Retinal fundus photograph · 1932 by 1910 pixels · FOV: 45 degrees.
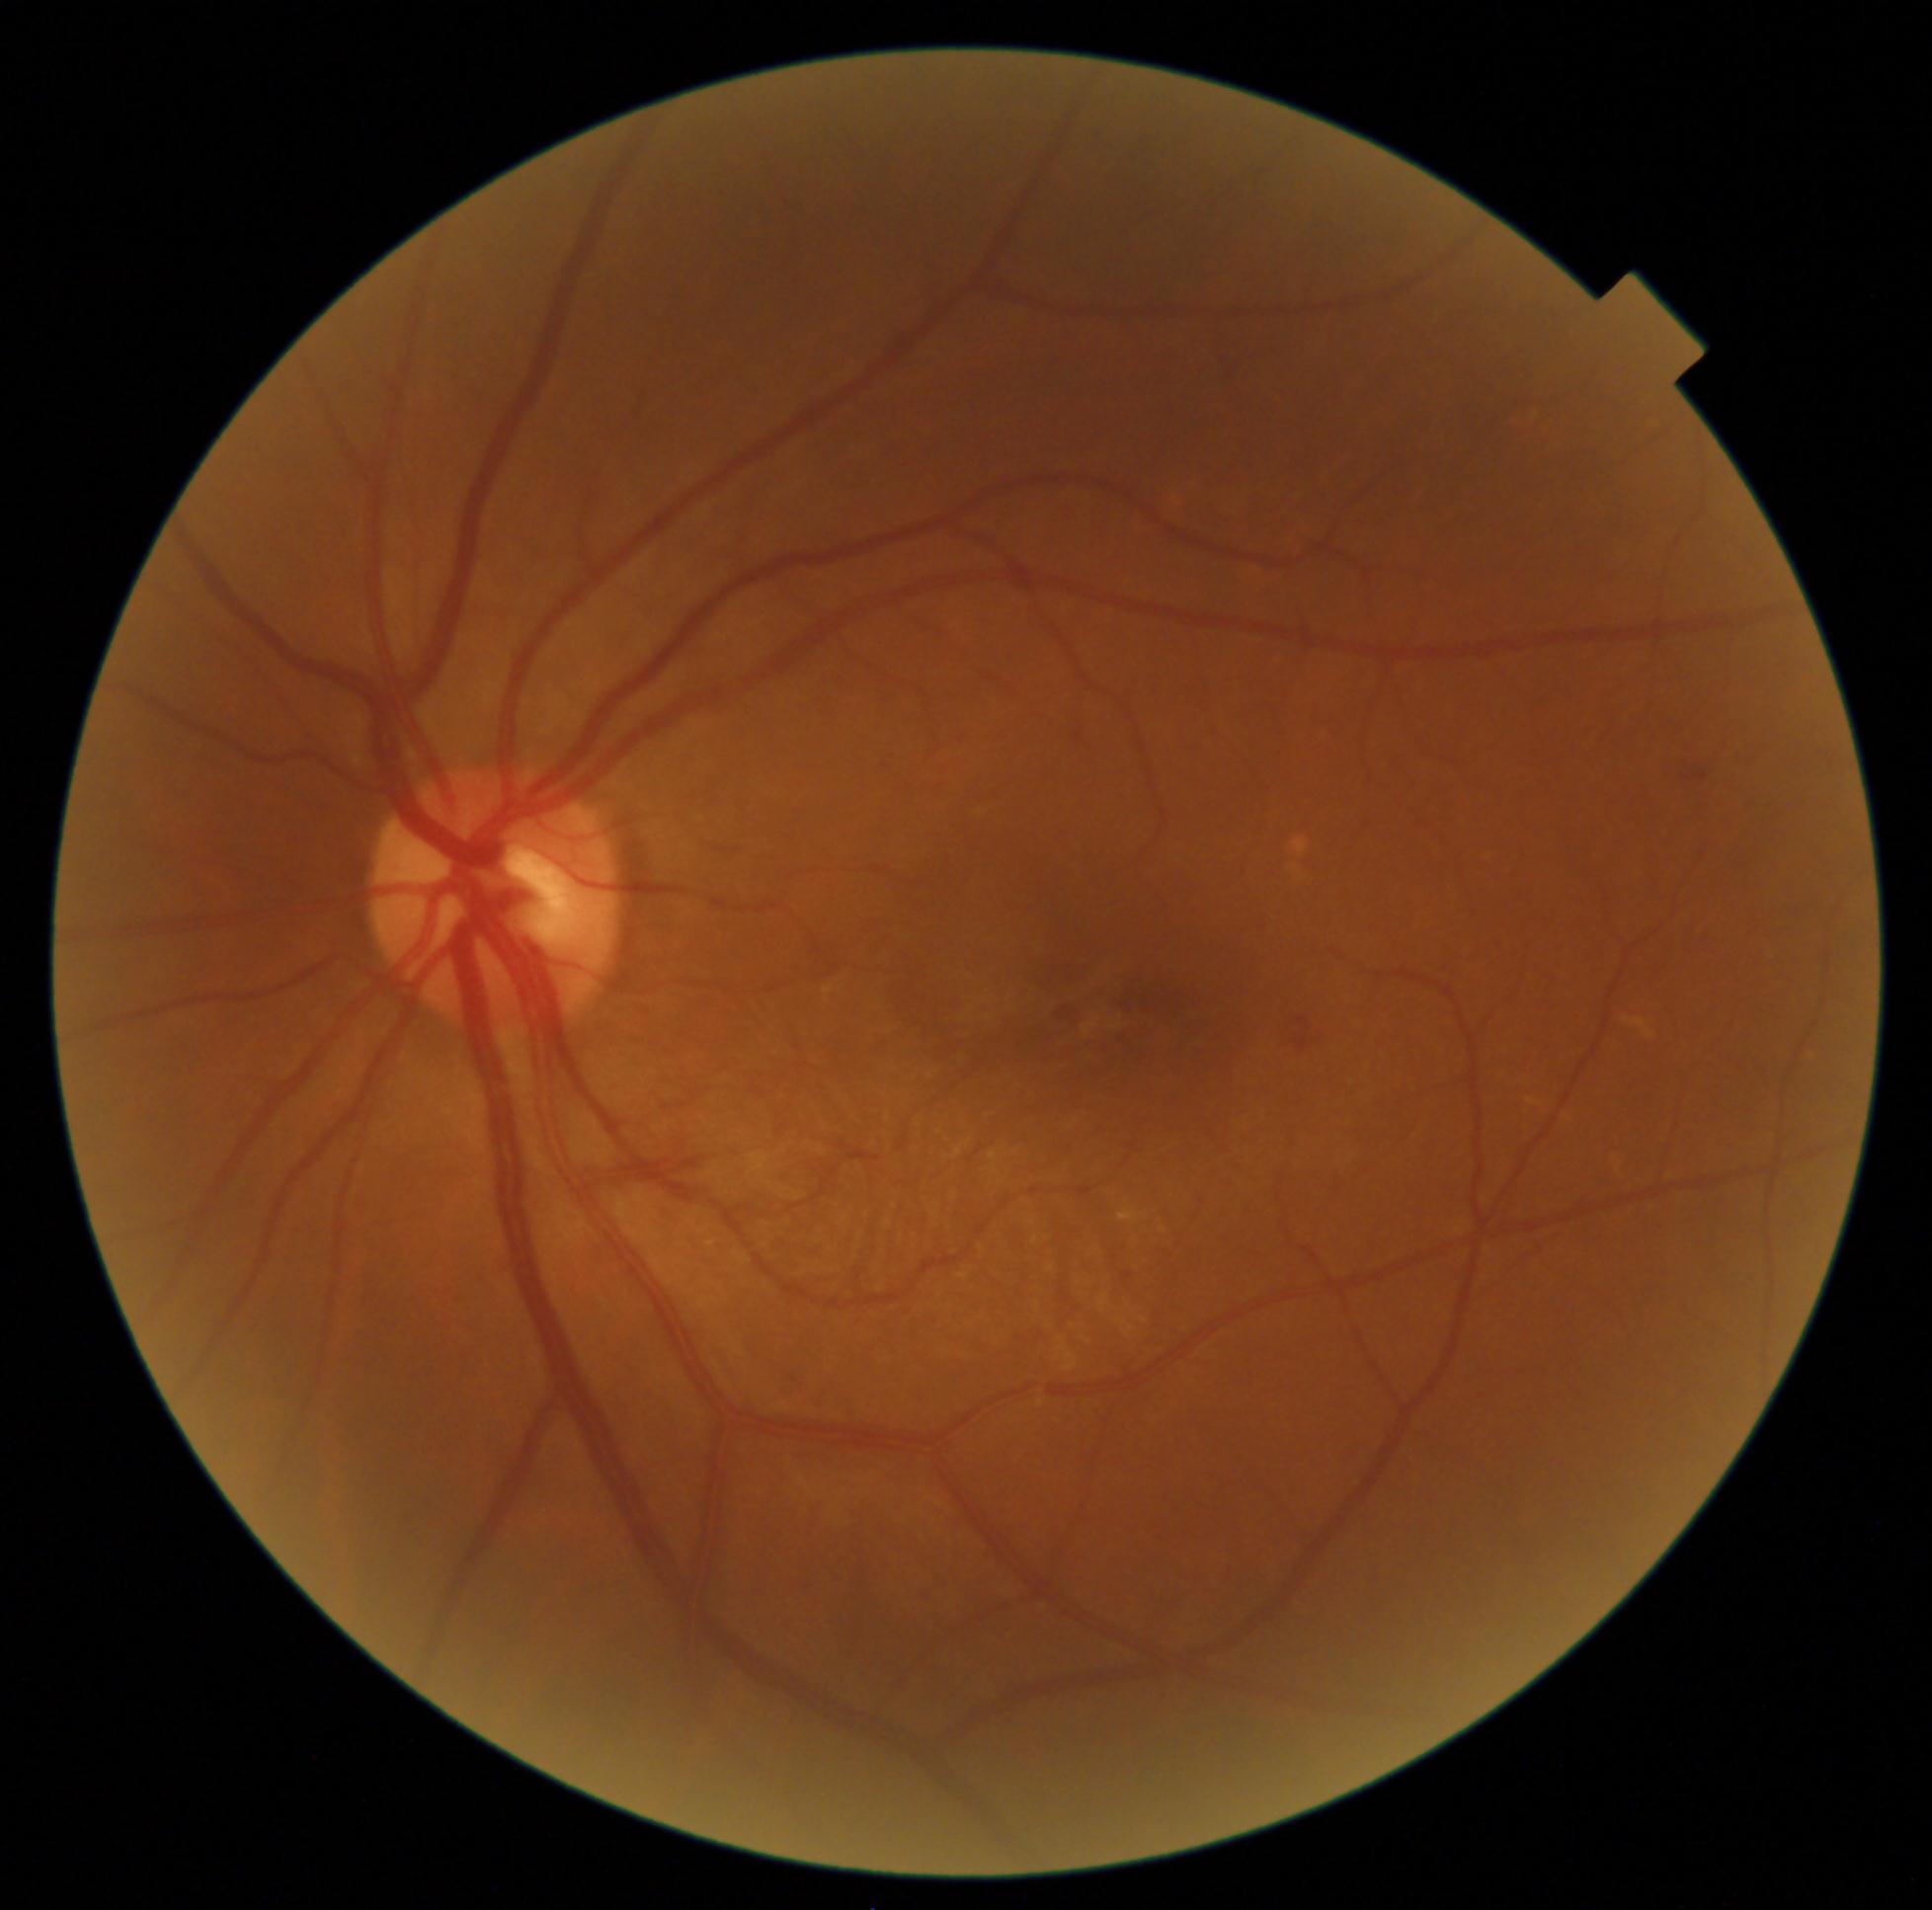 DR severity = moderate non-proliferative diabetic retinopathy (grade 2), DR class = non-proliferative diabetic retinopathy.